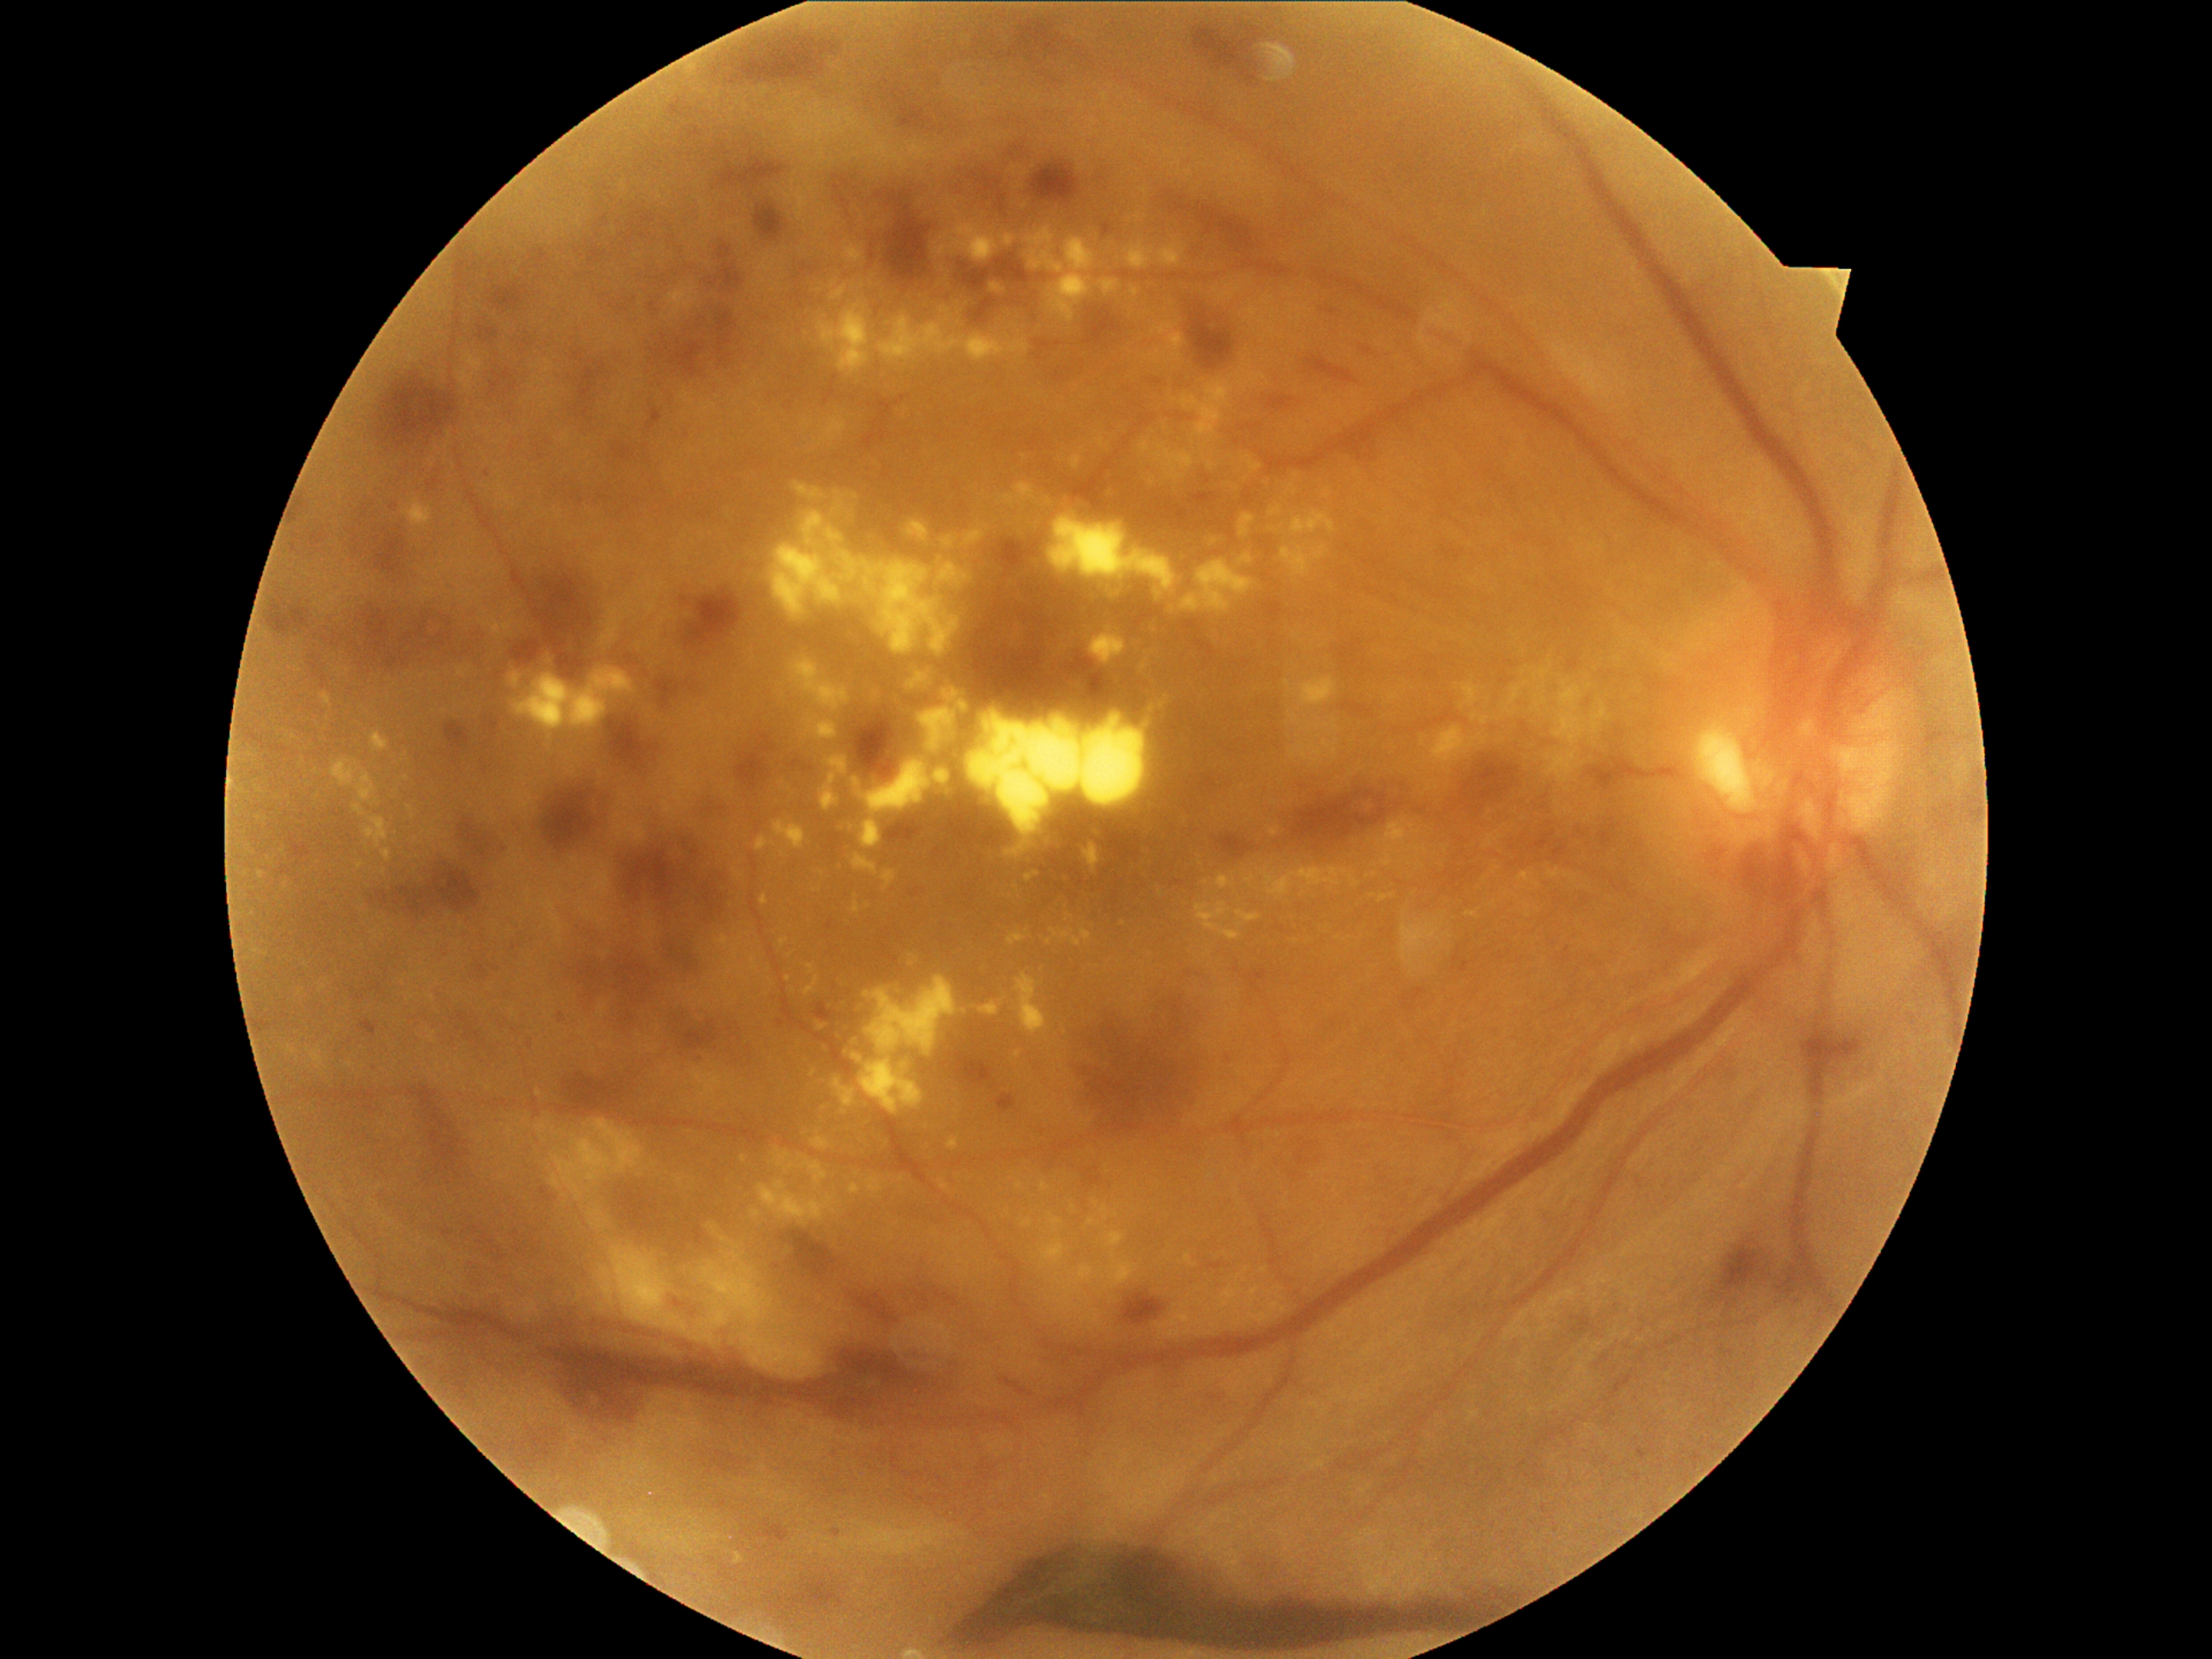
partial: true
dr_grade: 4
dr_grade_name: PDR
lesions:
  ex:
    - bbox=[1066, 914, 1074, 923]
    - bbox=[1419, 962, 1426, 970]
    - bbox=[933, 235, 948, 259]
    - bbox=[919, 707, 957, 754]
    - bbox=[1201, 451, 1214, 470]
    - bbox=[1211, 1284, 1245, 1312]
    - bbox=[1243, 873, 1255, 888]
    - bbox=[818, 301, 871, 375]
    - bbox=[882, 870, 897, 888]
    - bbox=[1167, 332, 1187, 361]
    - bbox=[1366, 871, 1378, 880]
    - bbox=[1523, 904, 1532, 919]
  ex_small:
    - point(1214, 542)
    - point(1588, 820)
    - point(744, 1159)
    - point(1213, 1326)
    - point(735, 997)
    - point(1167, 697)
    - point(782, 854)
    - point(1567, 812)